Color fundus photograph.
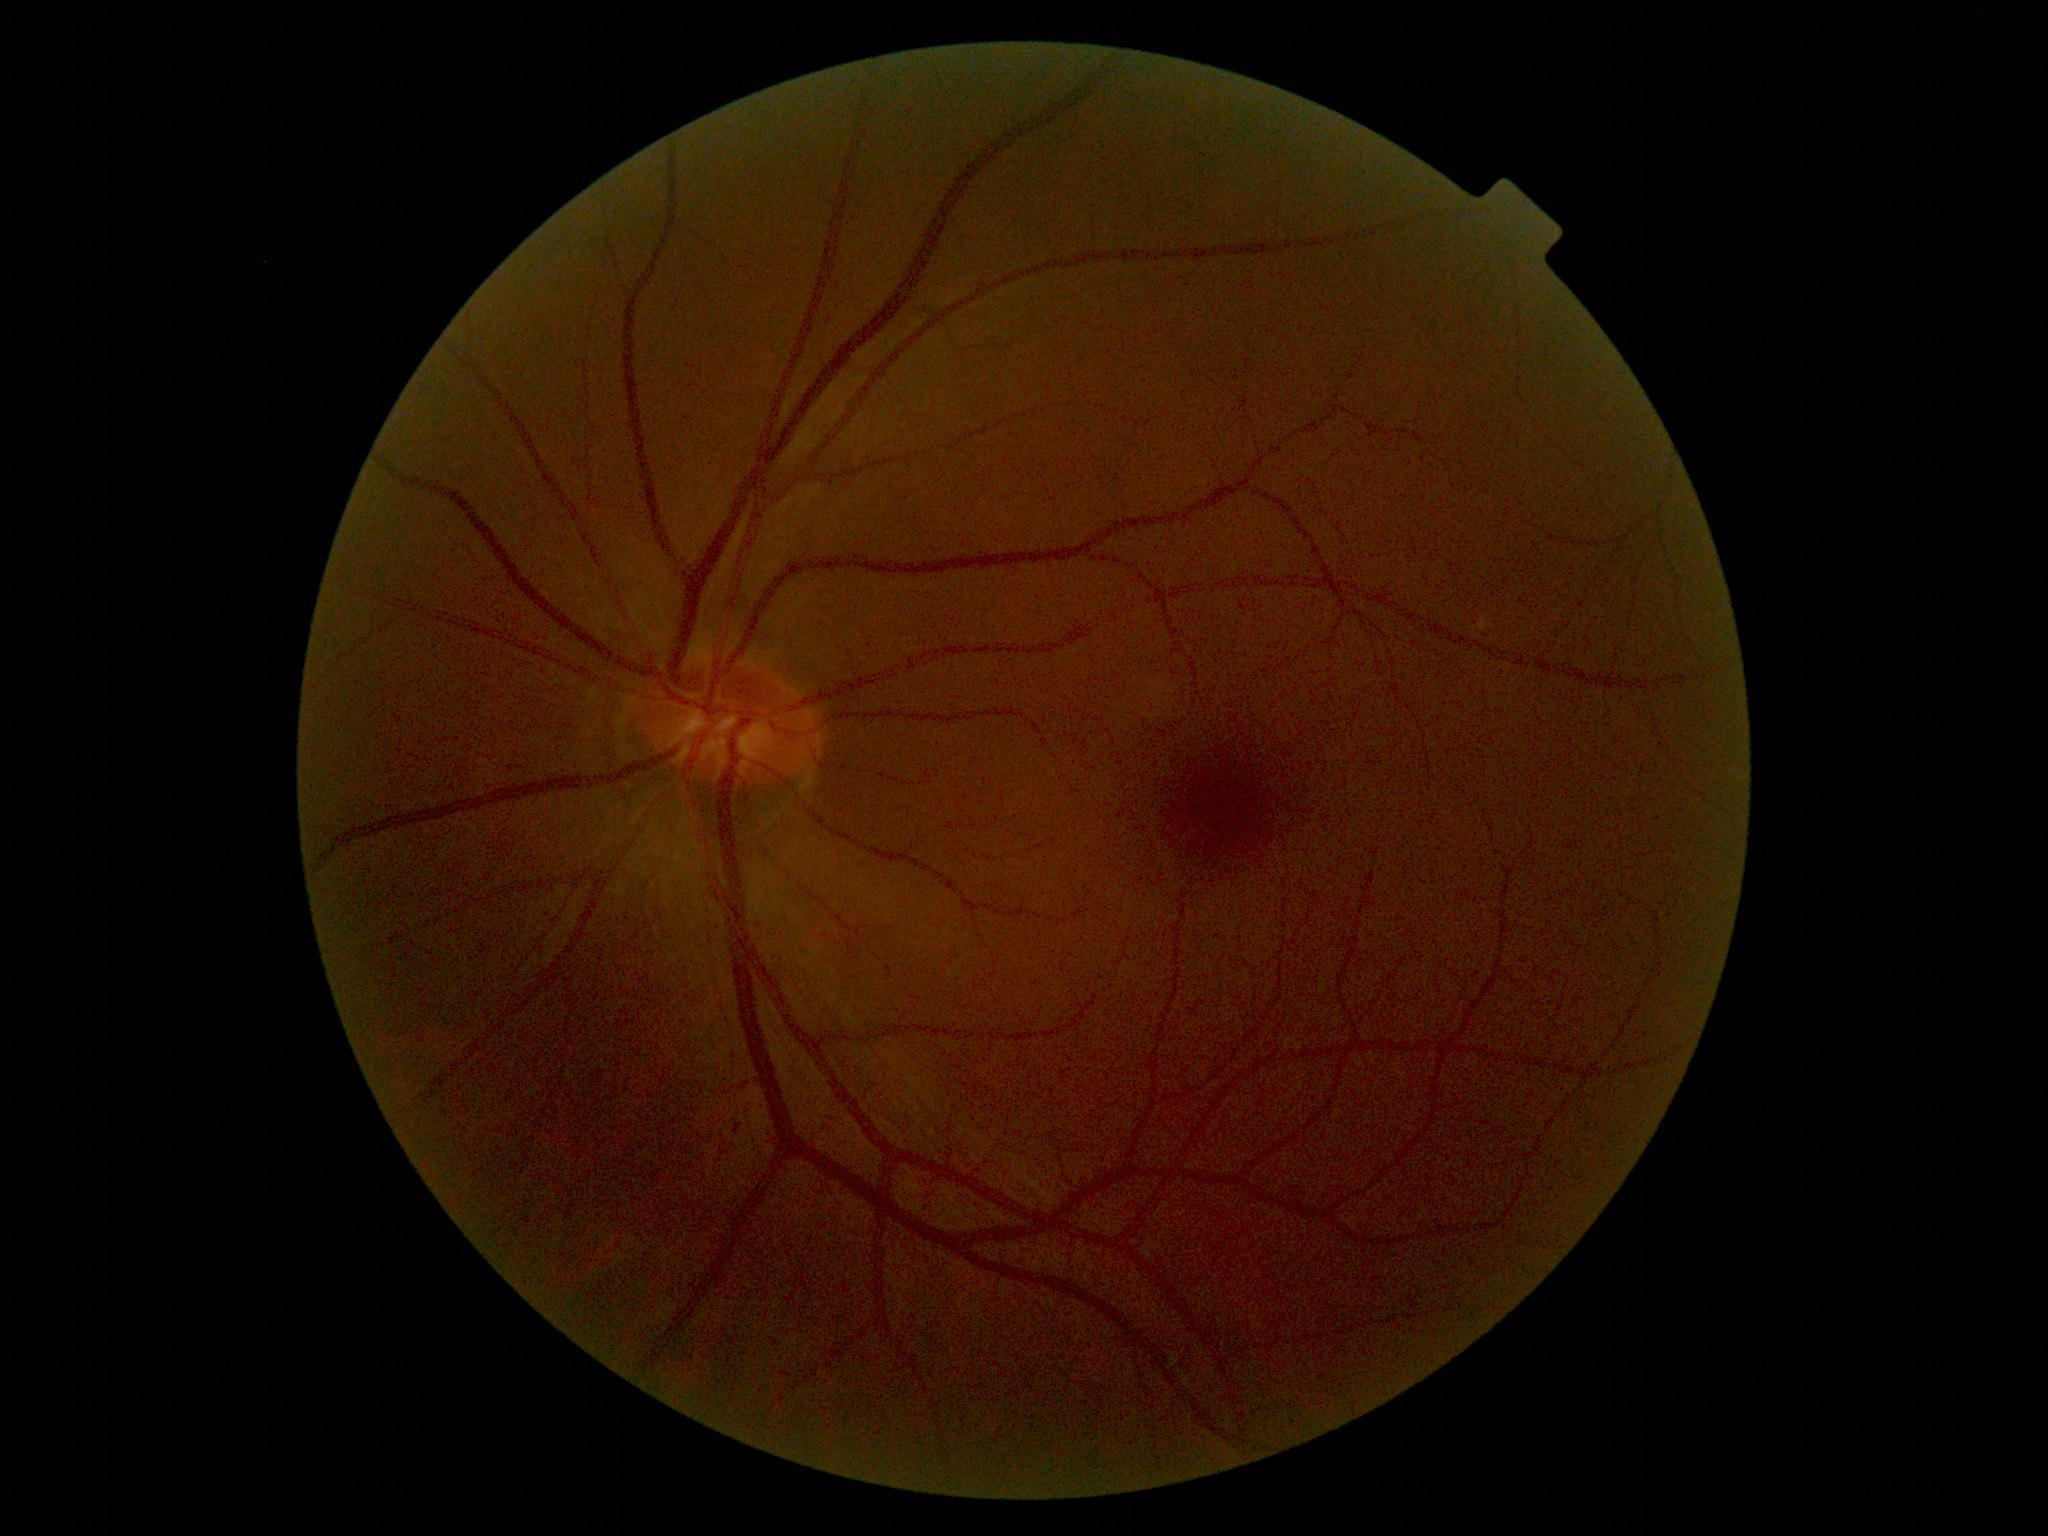
DR = no apparent retinopathy (grade 0).